2048x1536px — 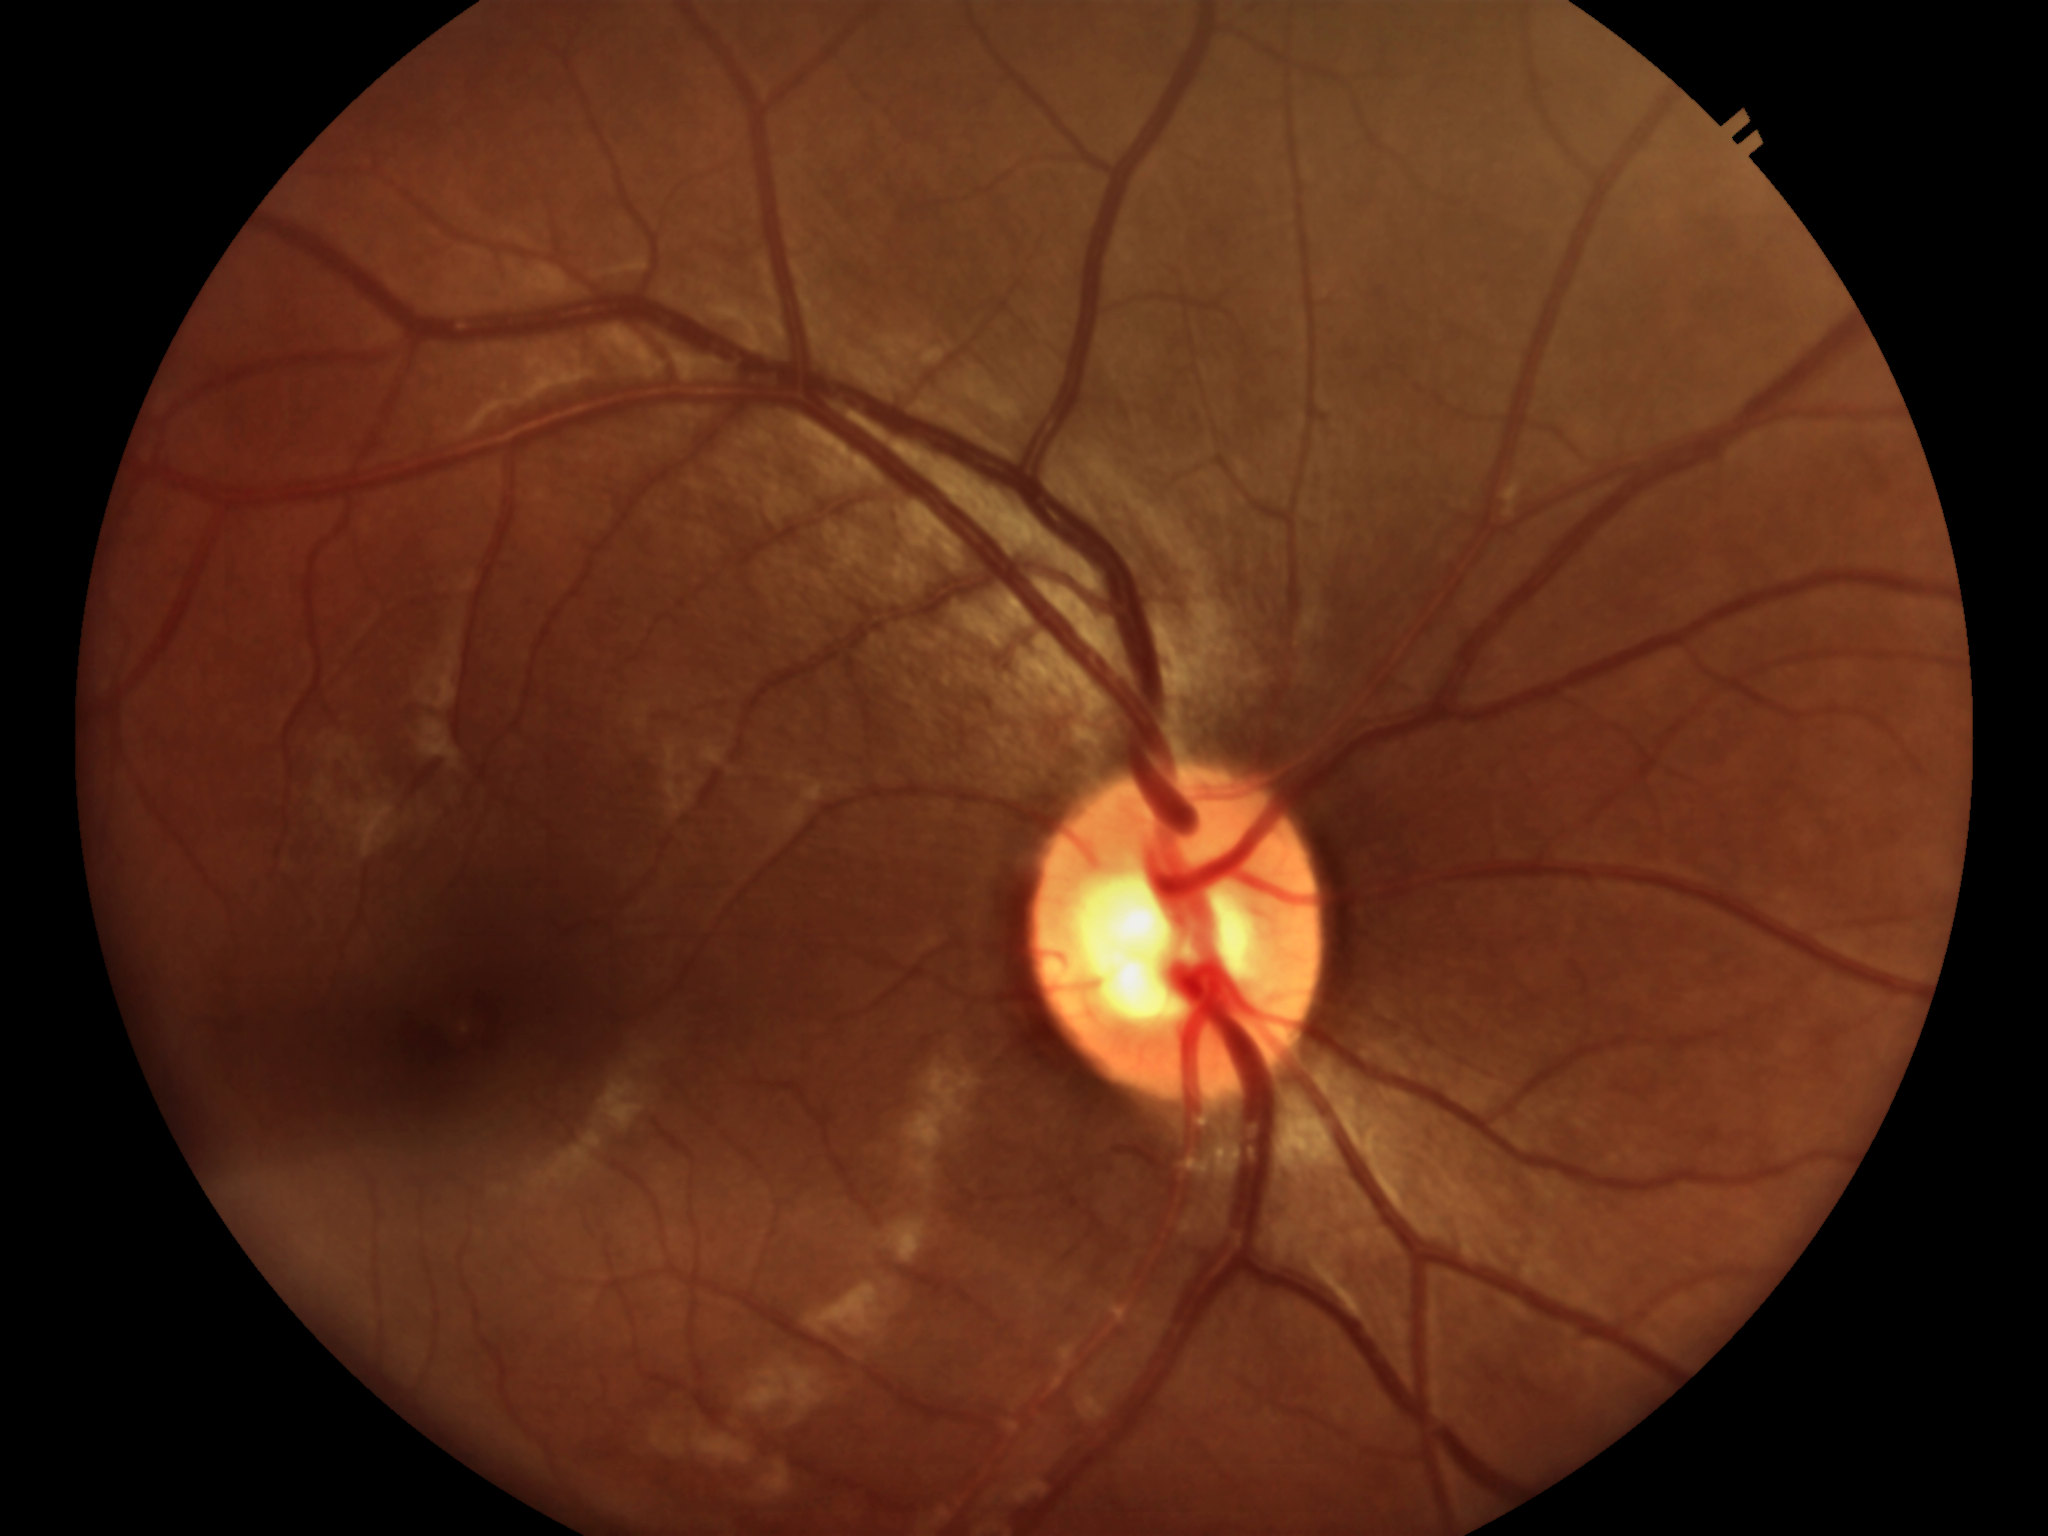

Area C/D ratio (ACDR) of 0.31. No signs of glaucoma (5/5 ophthalmologists in agreement). Vertical cup-to-disc ratio (VCDR) of 0.51.